Color fundus photograph:
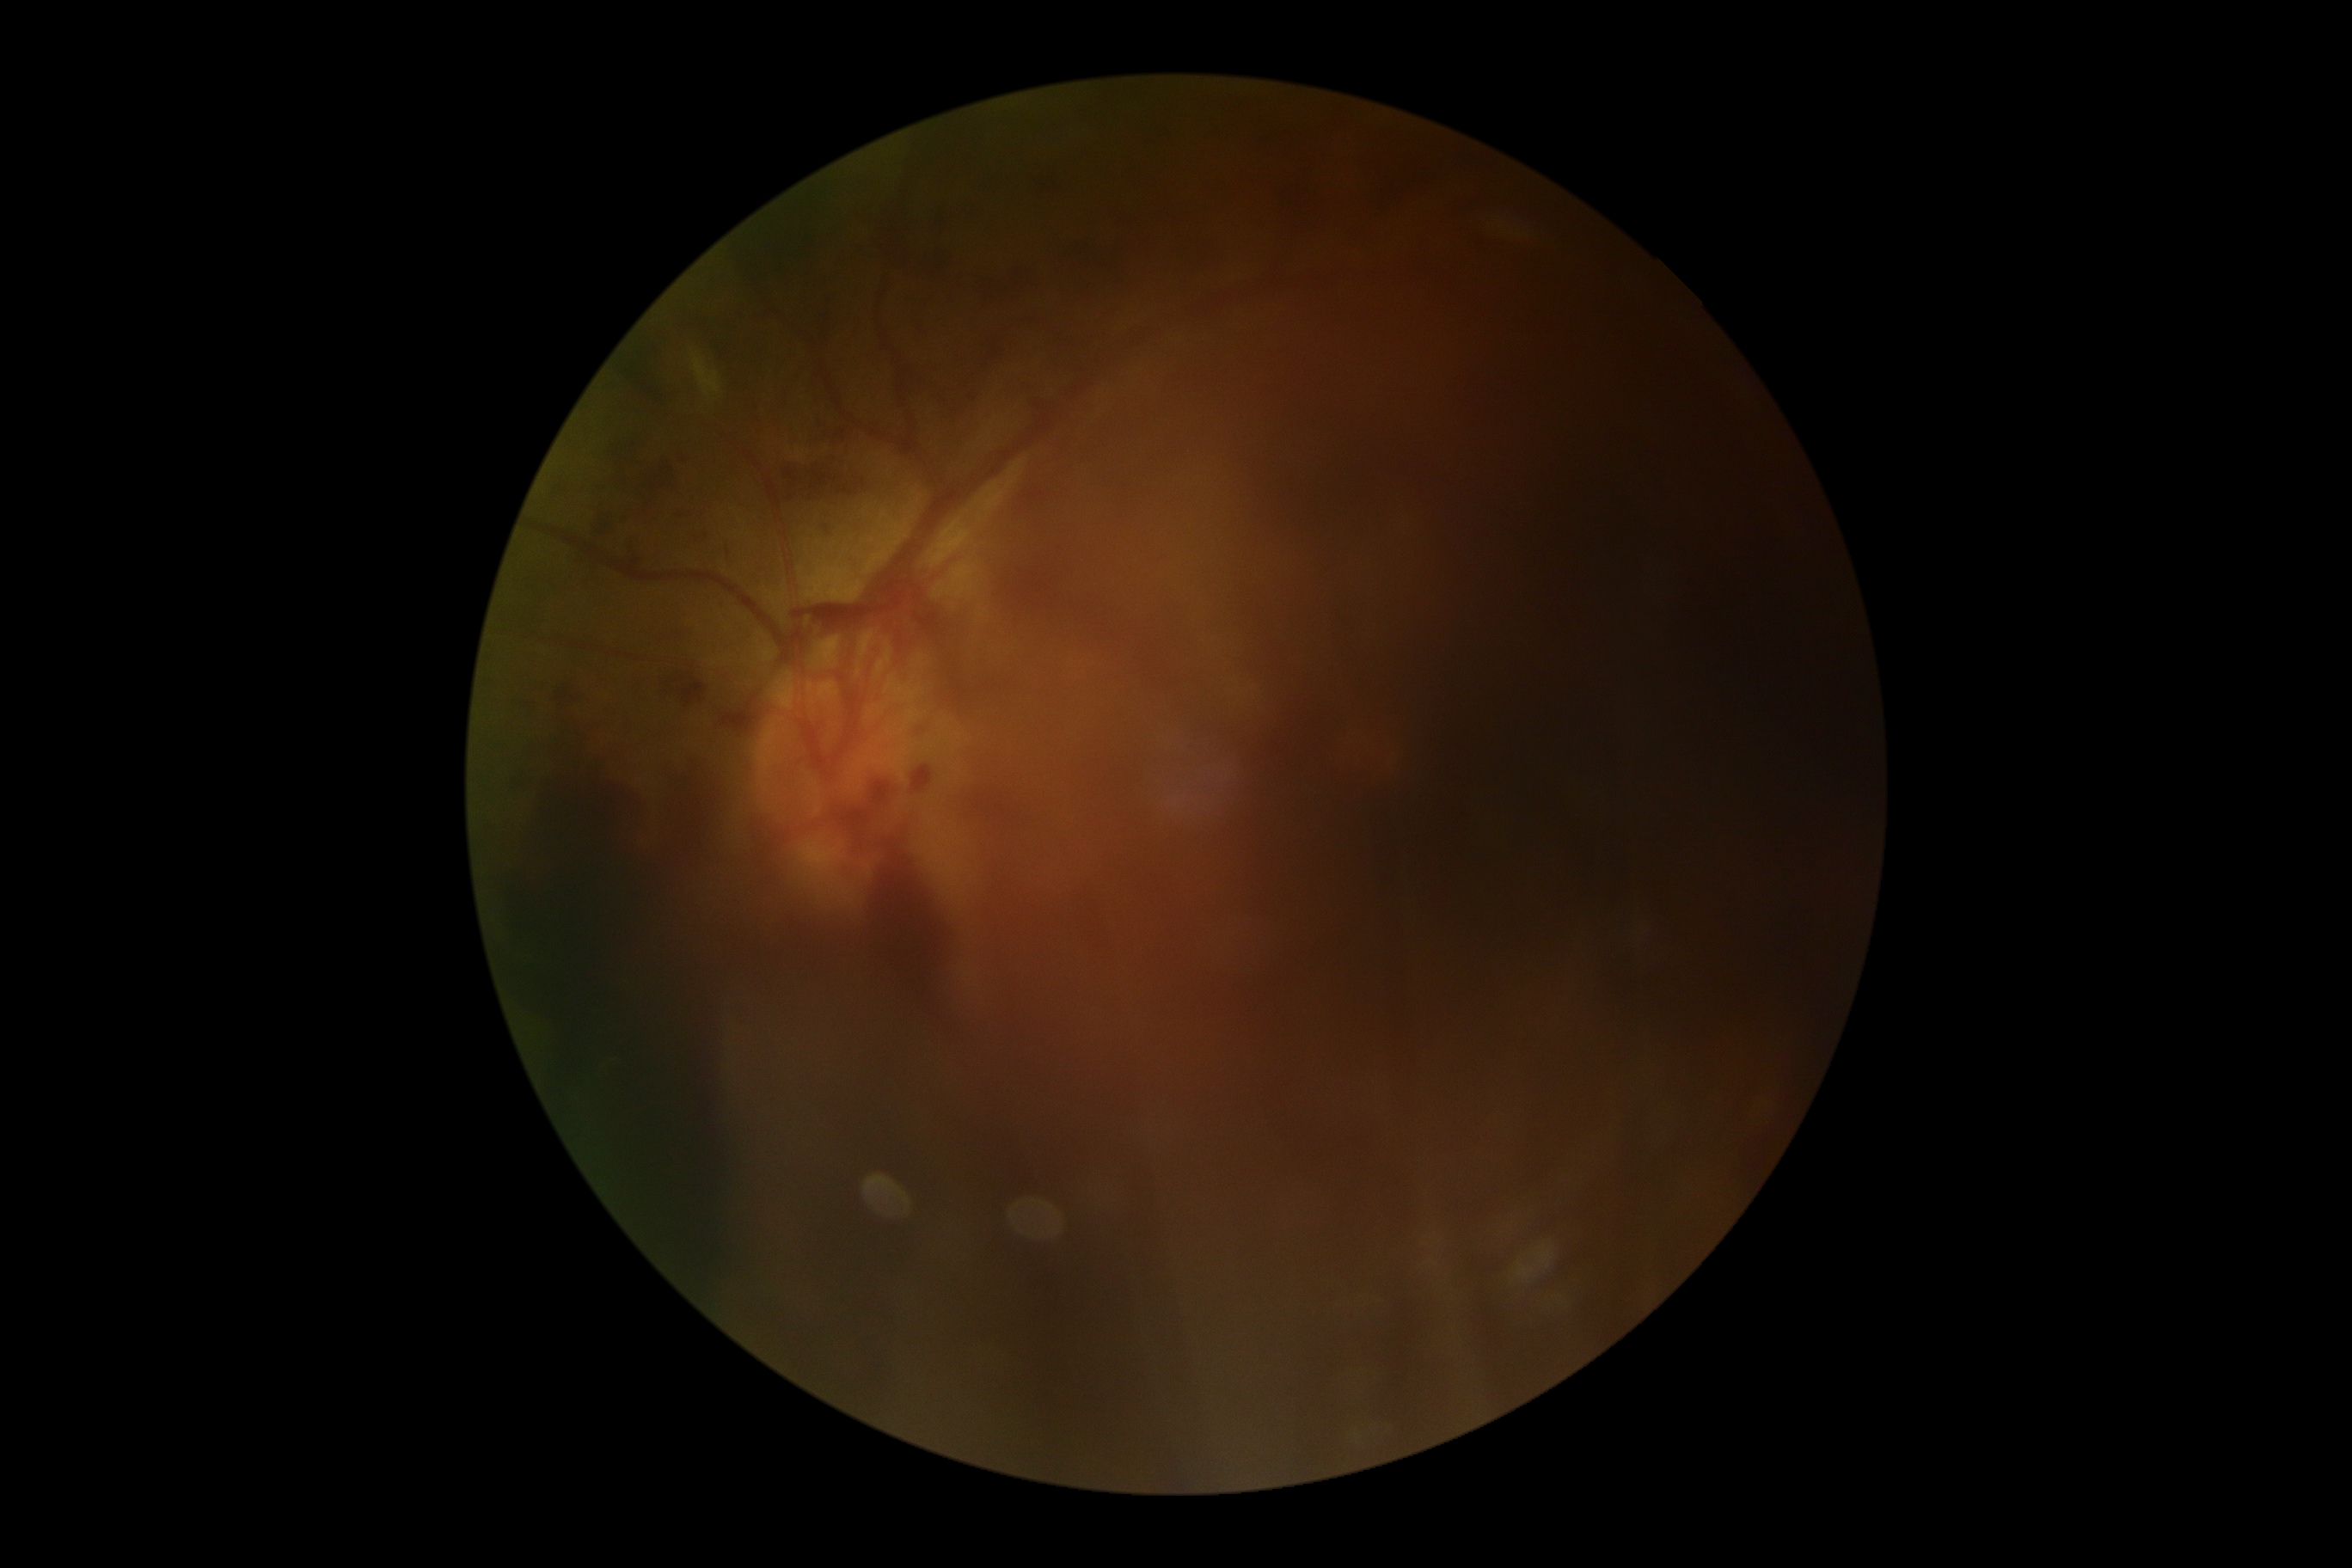
Diabetic retinopathy grade is proliferative diabetic retinopathy (4).